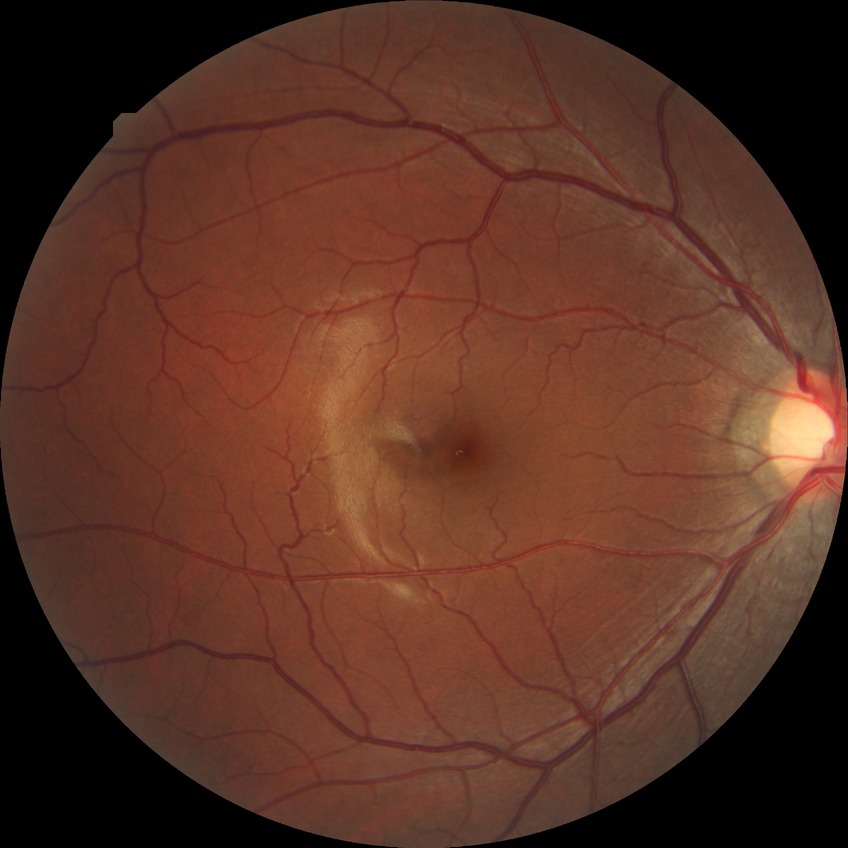
Diabetic retinopathy (DR) is no diabetic retinopathy (NDR).